848 x 848 pixels: 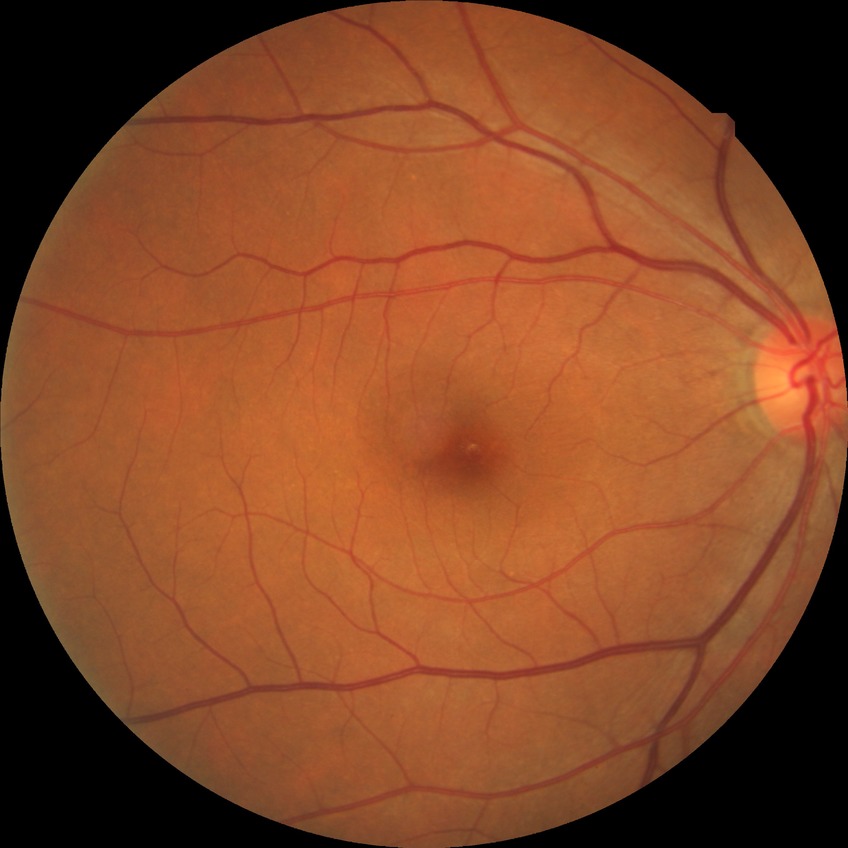
{"davis_grade": "no diabetic retinopathy"}